Centered on the optic disc.
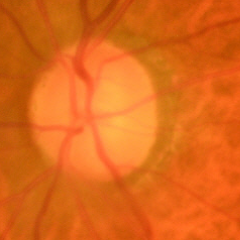
Optic nerve head appearance consistent with early glaucomatous changes.